1932 x 1932 pixels
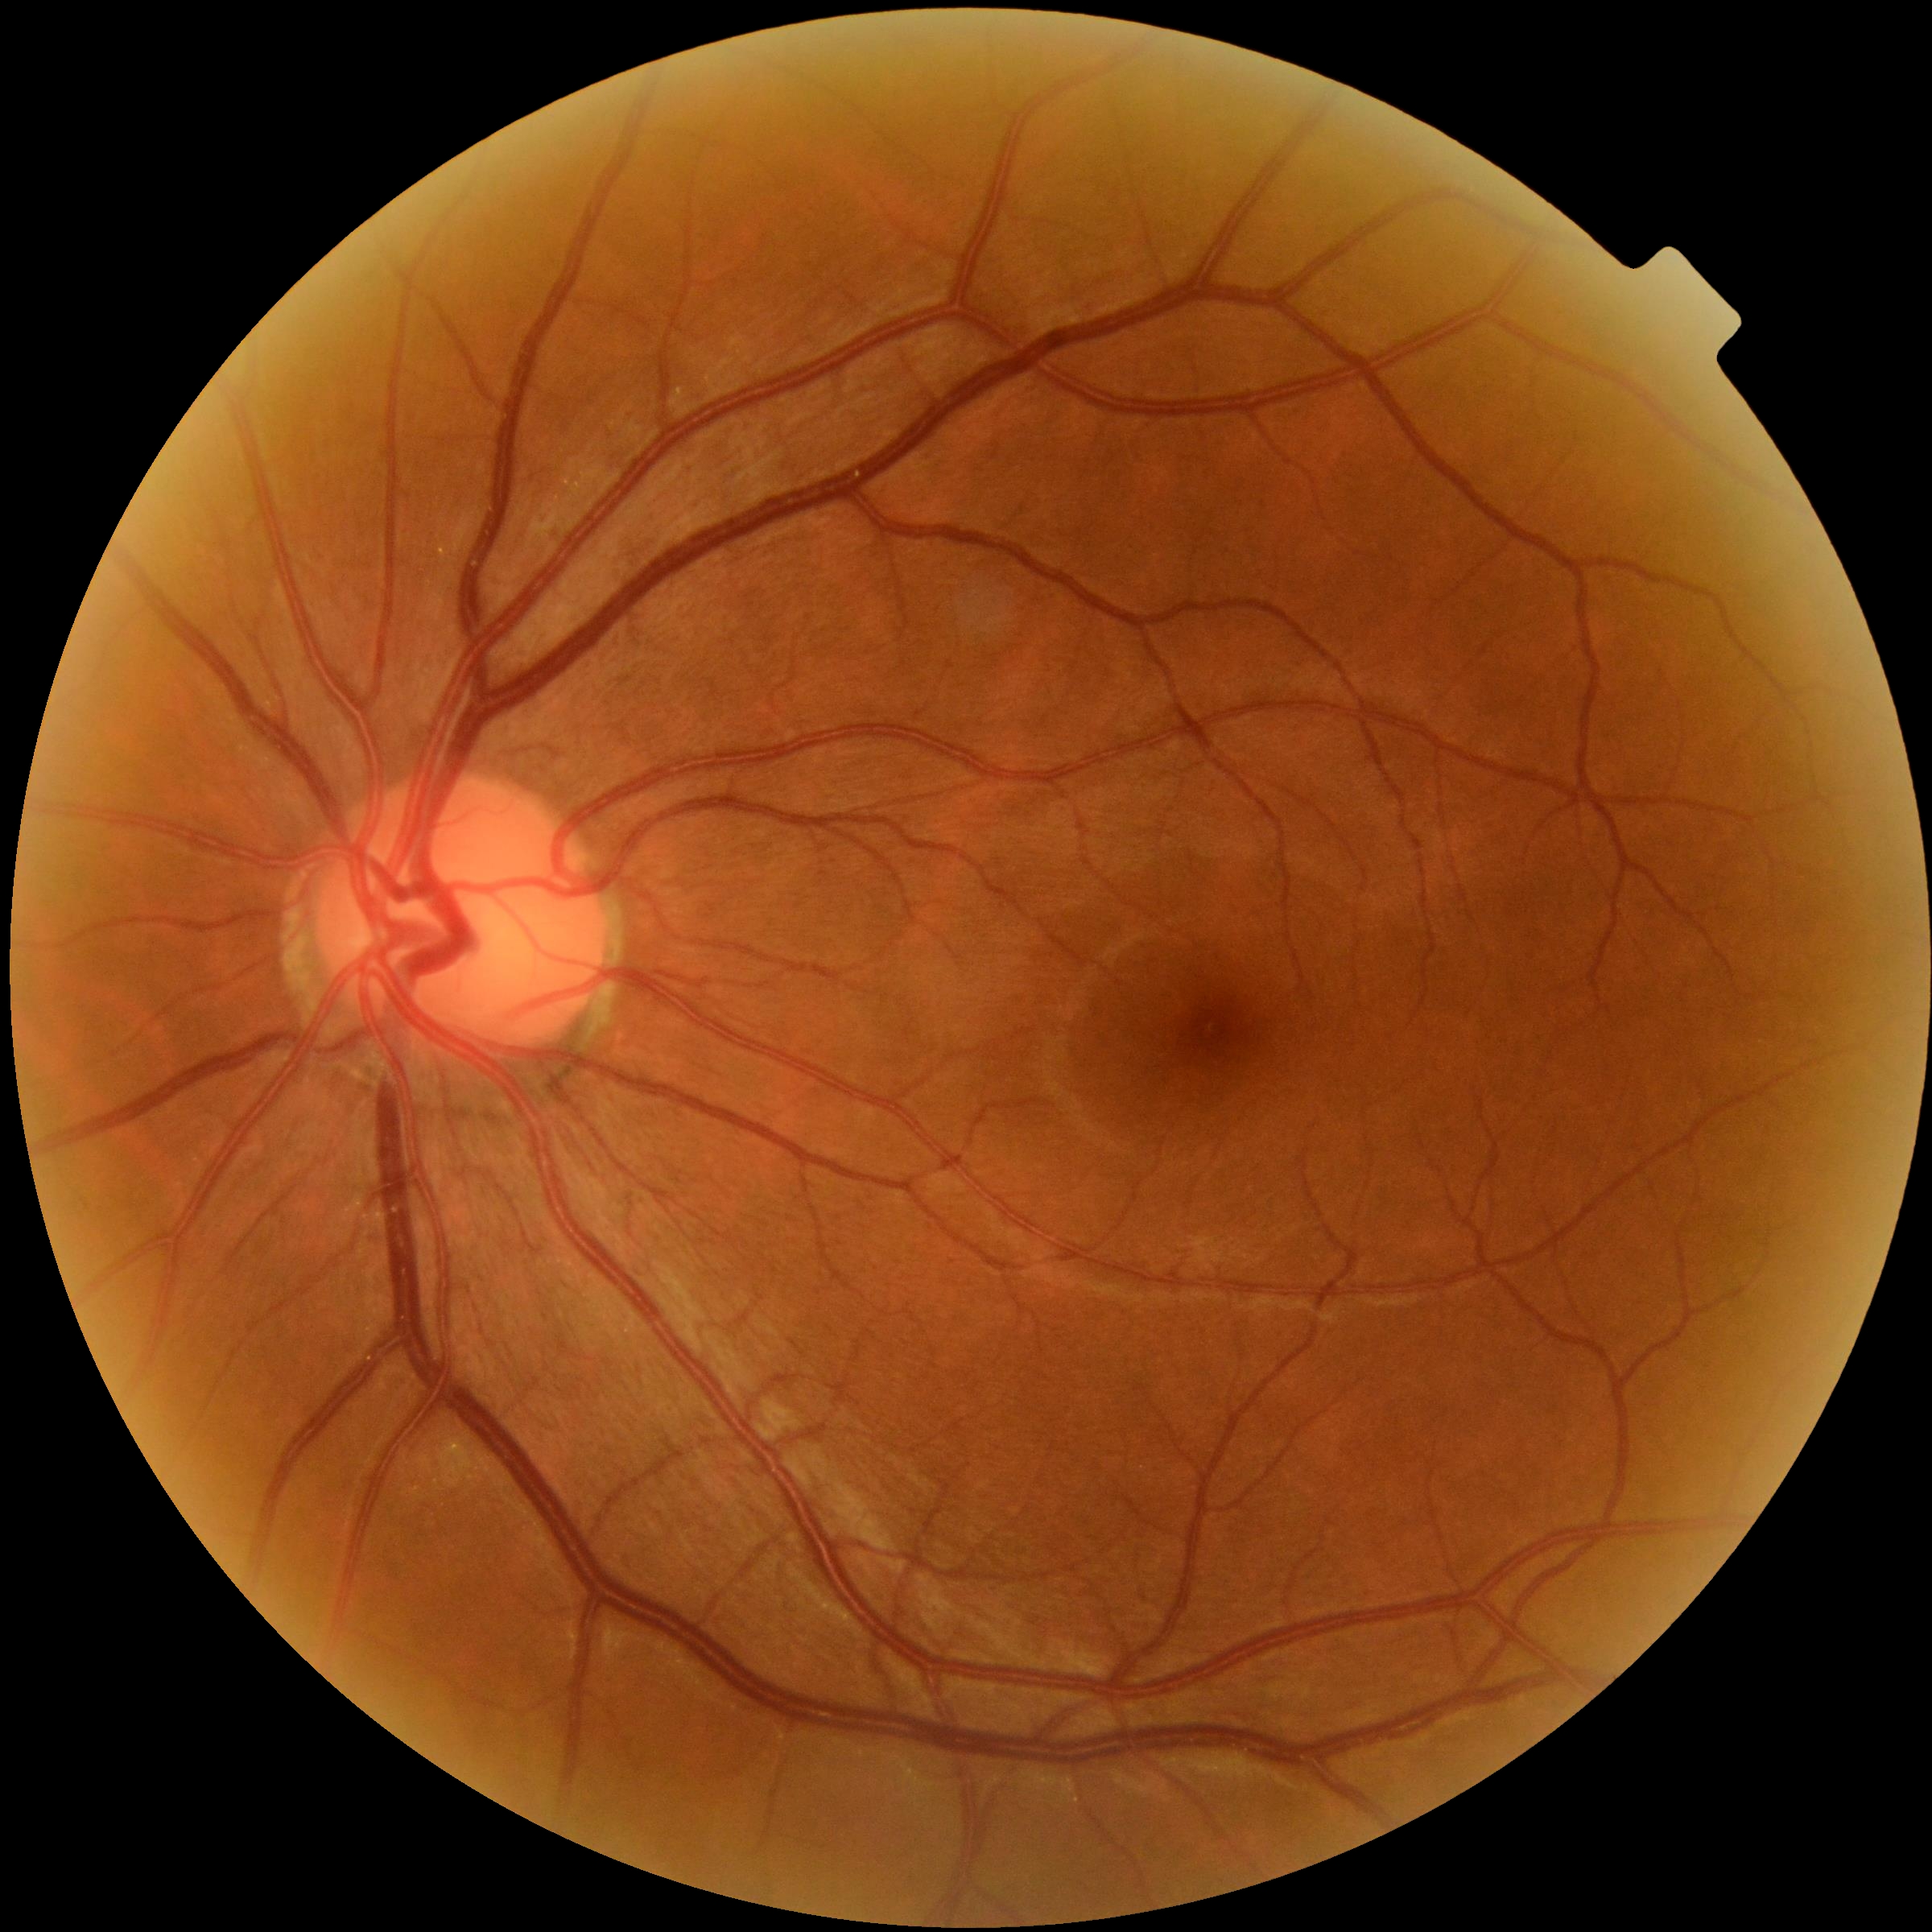 {
  "dr_grade": "grade 0 (no apparent retinopathy)",
  "dr_impression": "no DR findings"
}